Wide-field fundus photograph of an infant; 1440 x 1080 pixels; Natus RetCam Envision, 130° FOV — 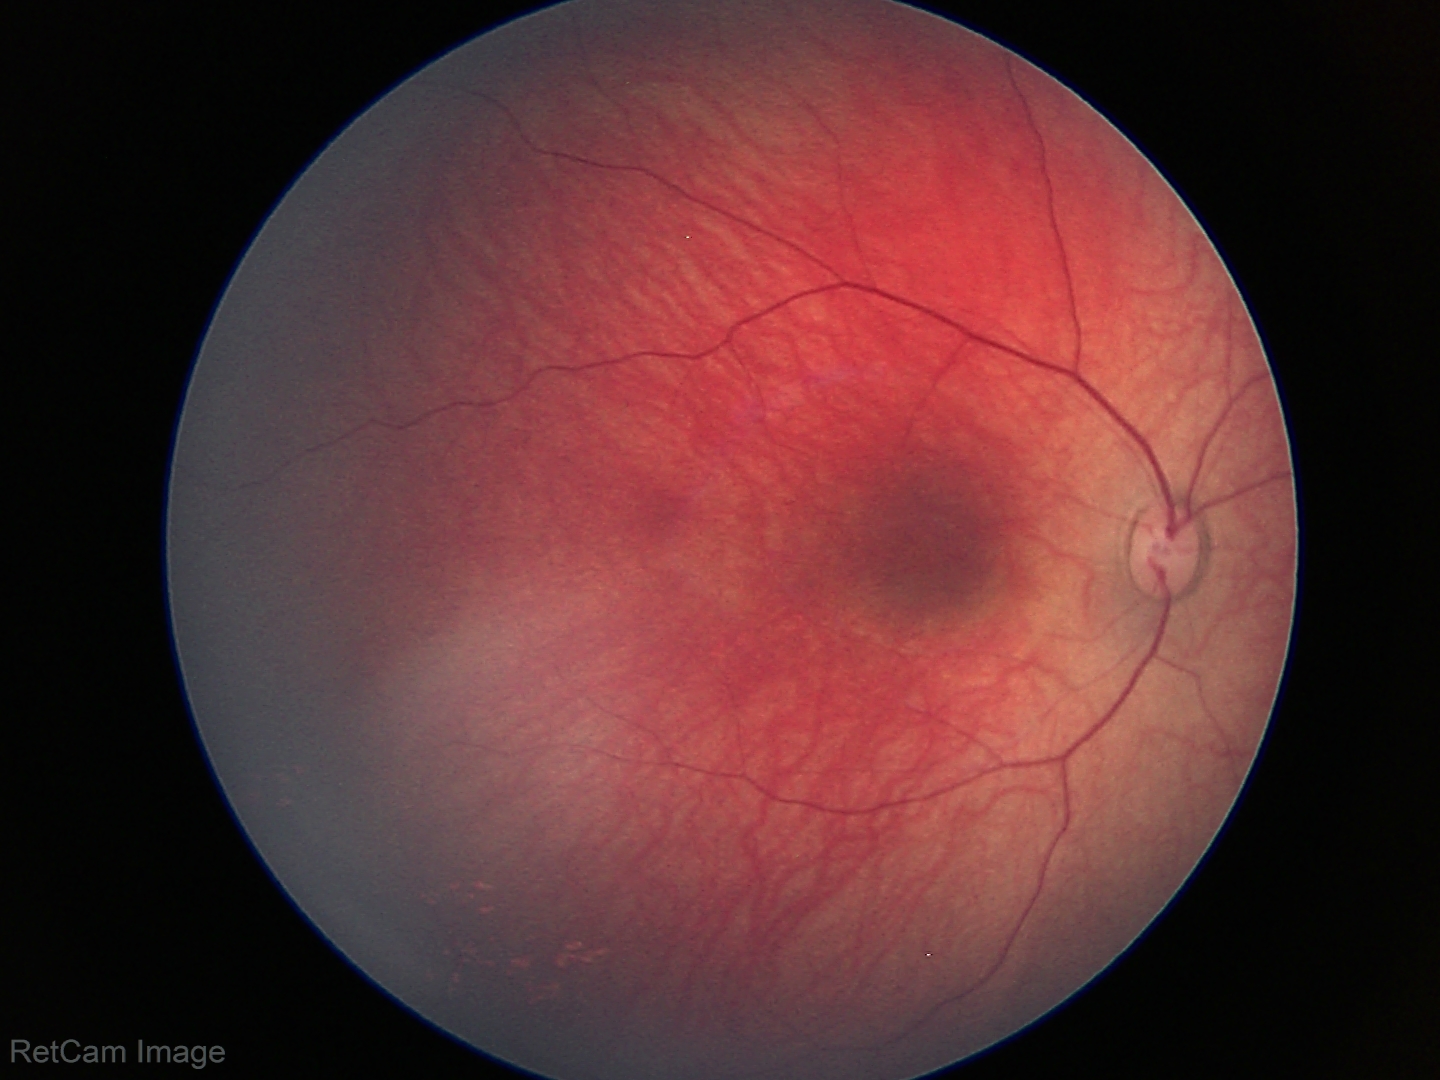
Assessment: normal retinal appearance.